Wide-field contact fundus photograph of an infant · acquired on the Clarity RetCam 3:
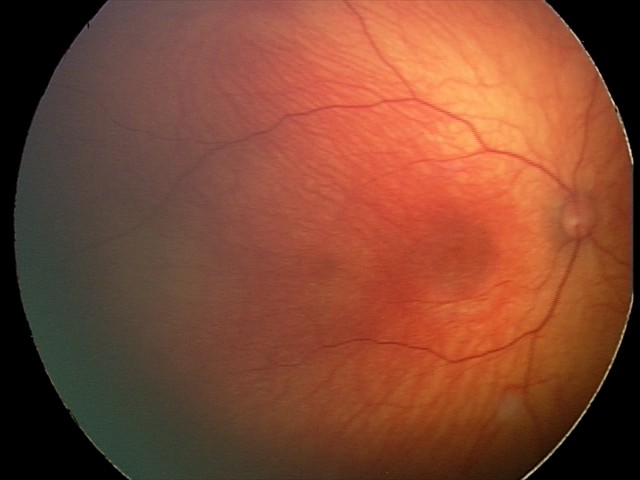
Normal screening examination.